Clarity RetCam 3, 130° FOV; infant wide-field retinal image.
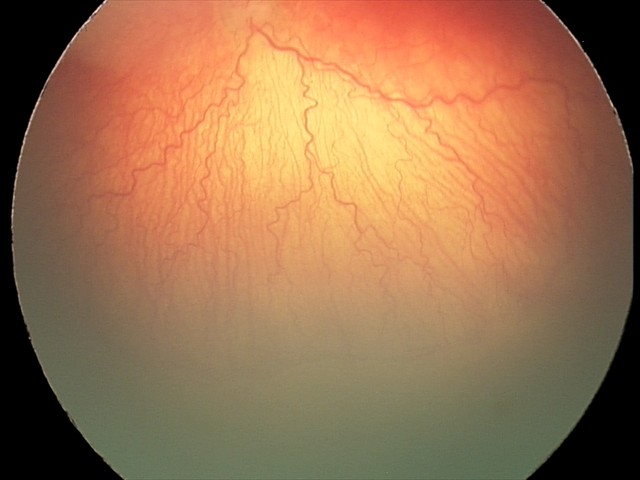

Plus form = present, impression = aggressive retinopathy of prematurity.